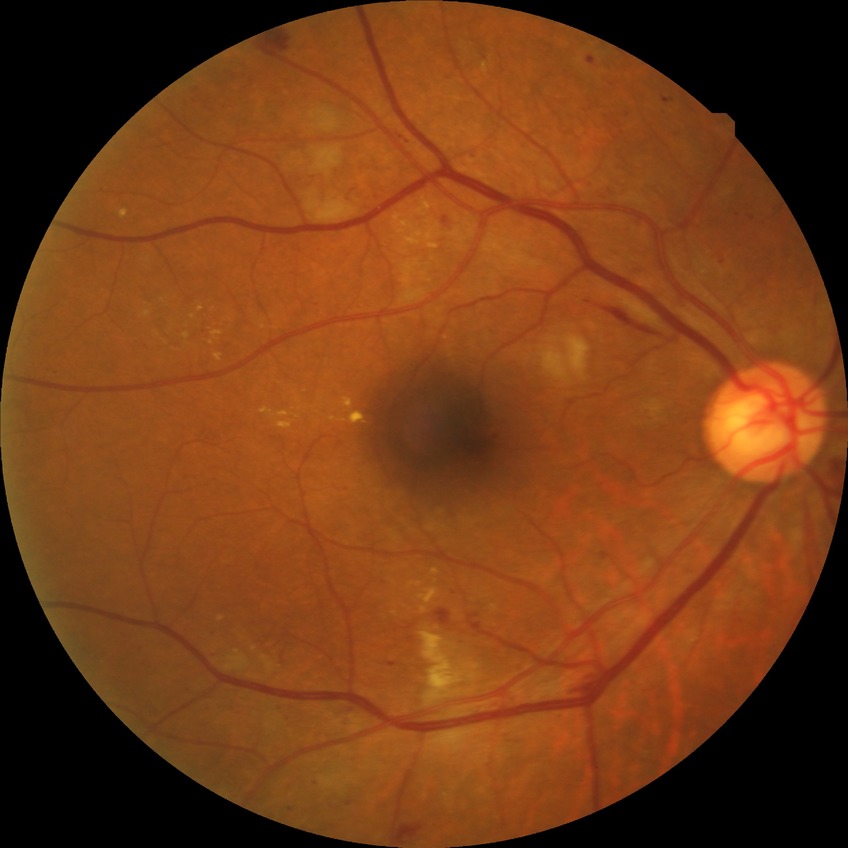 davis_grade: pre-proliferative diabetic retinopathy (PPDR)